45° field of view; color fundus photograph
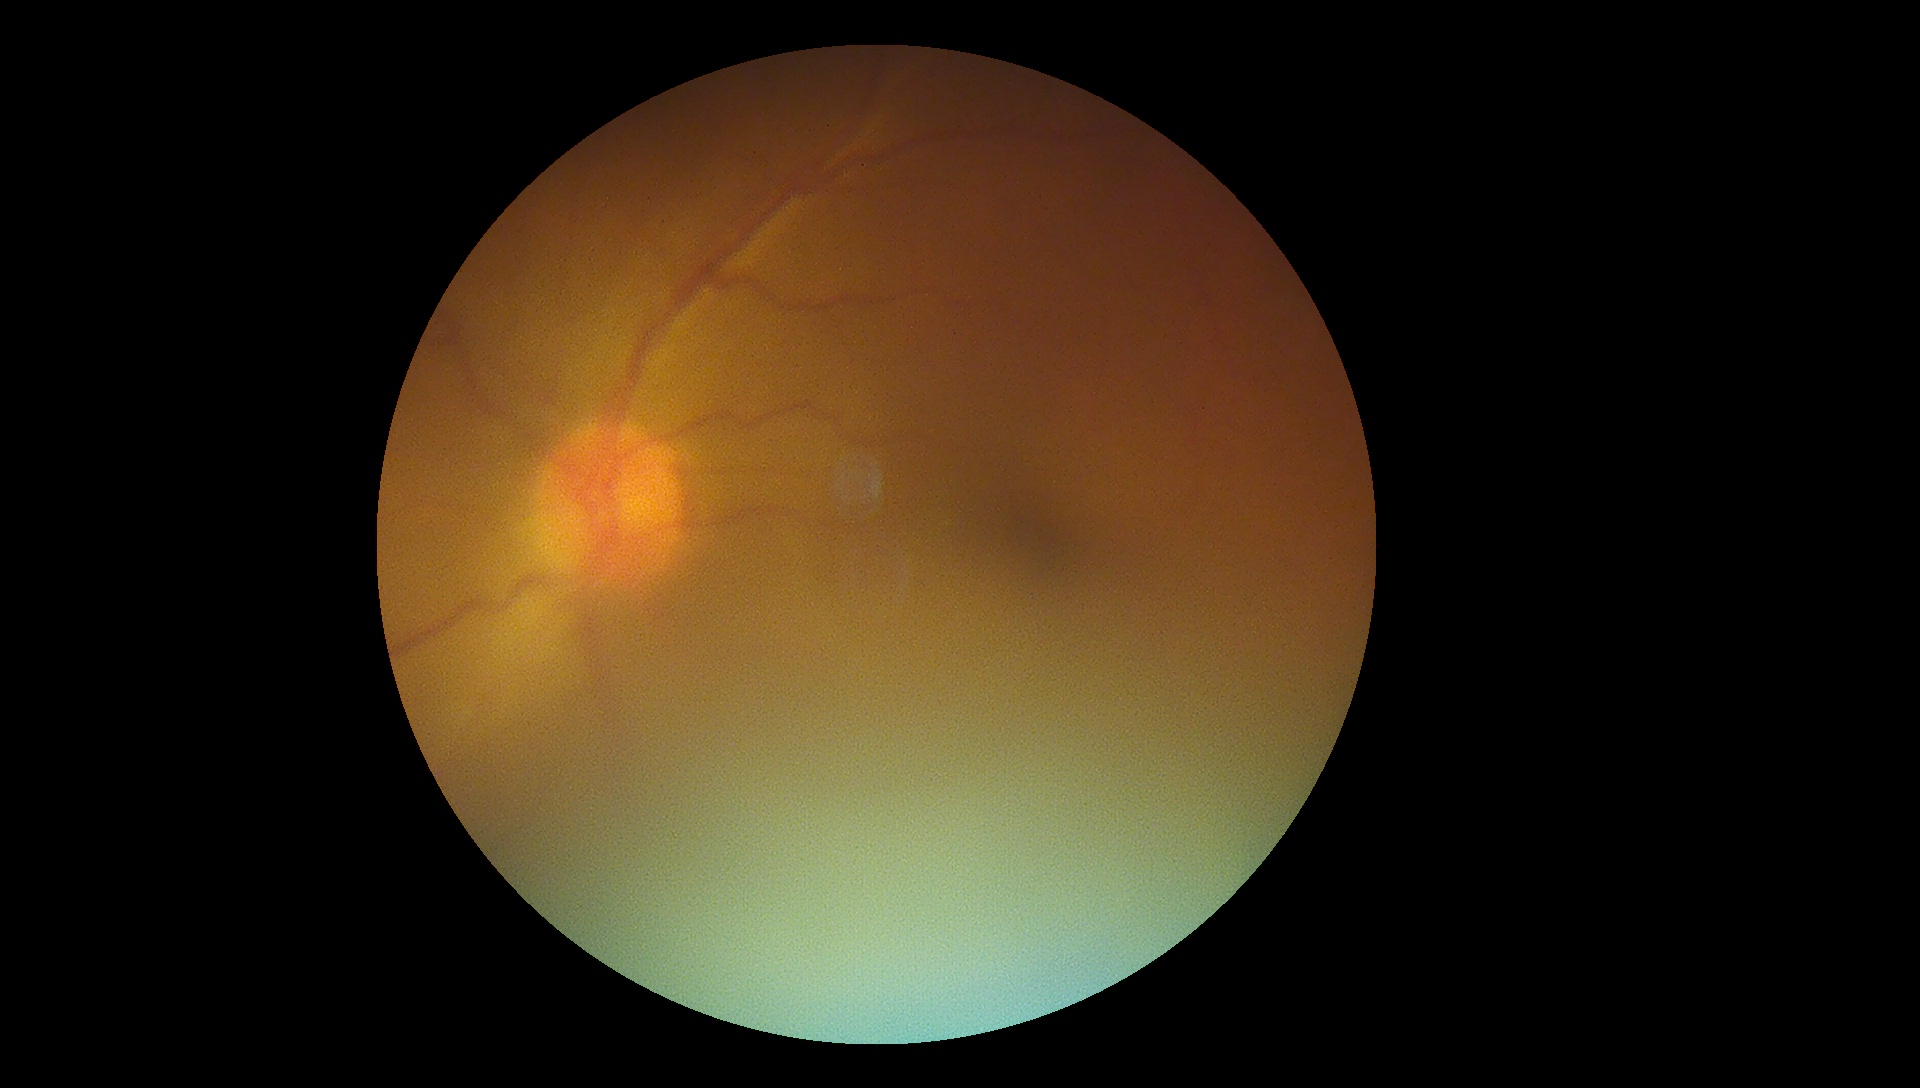 Diabetic retinopathy grade: ungradable.